2212x1661; centered on the optic disc; captured without pupil dilation; refraction: sphere +1.75 D, cylinder -1.5 D, axis 100°; axial length: 23.03 mm; corneal thickness: 553 µm; 69 years old; sex: F — 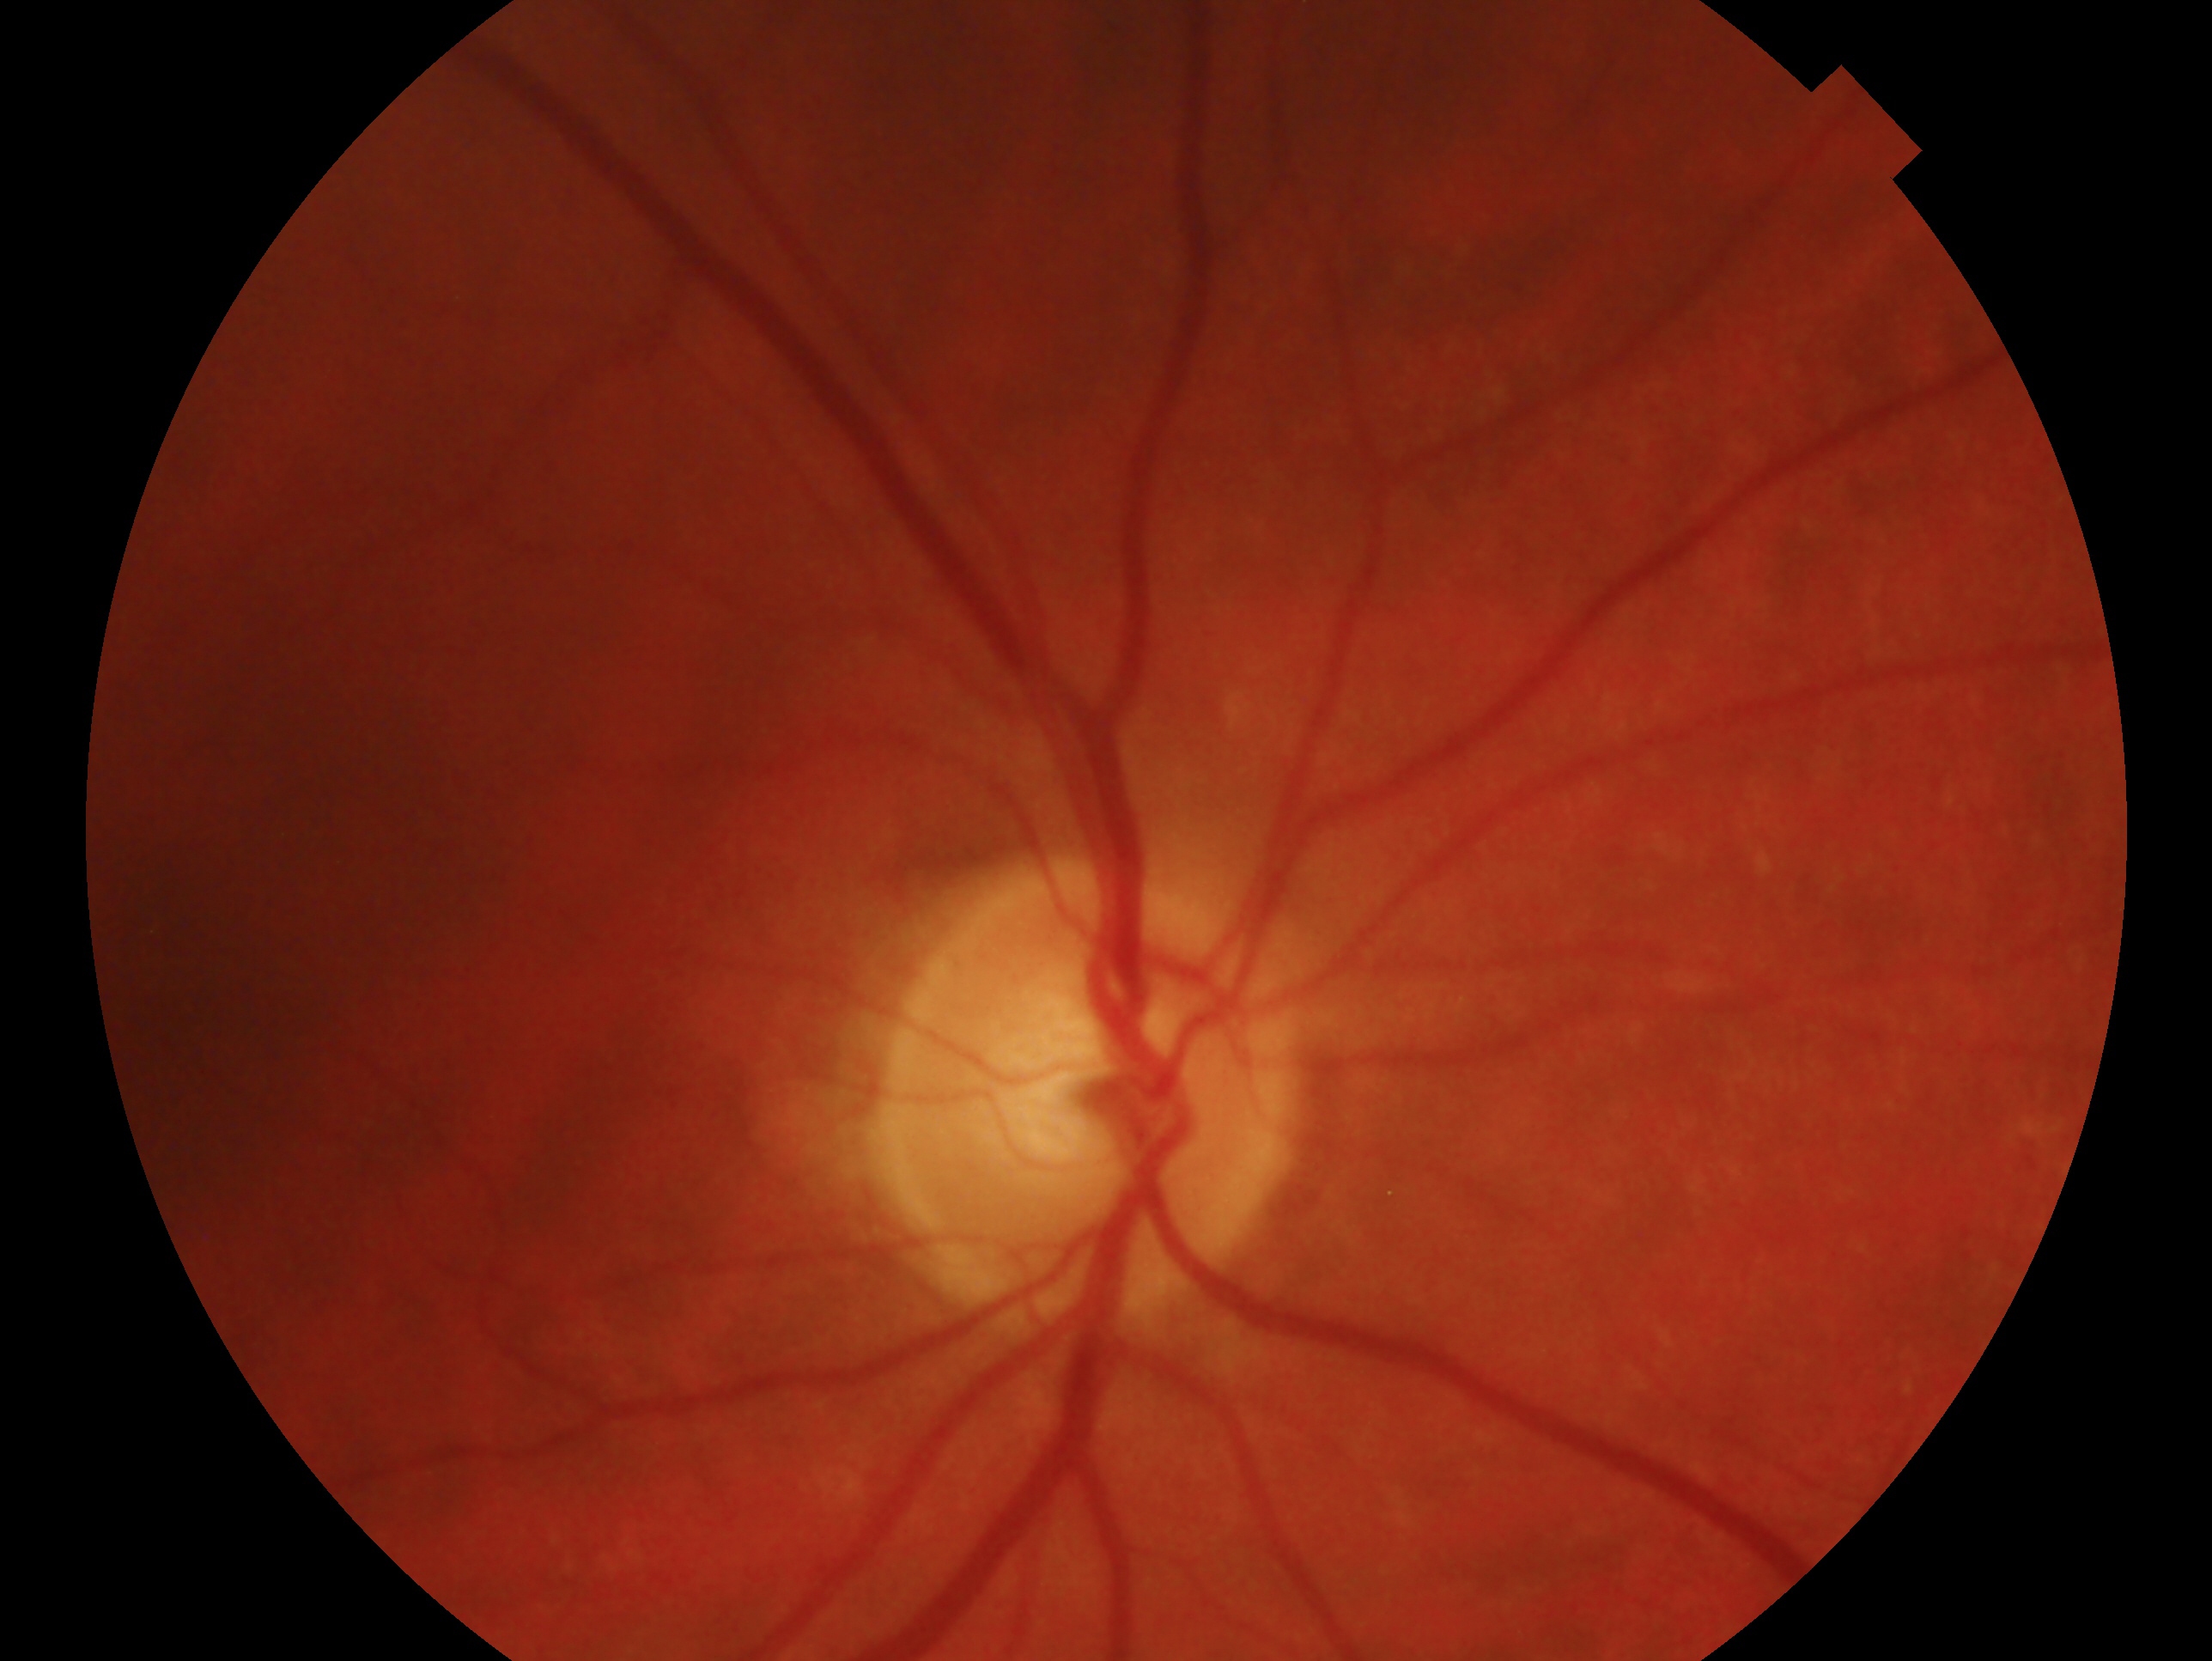

This is the OD. Clinical classification — negative for glaucoma.